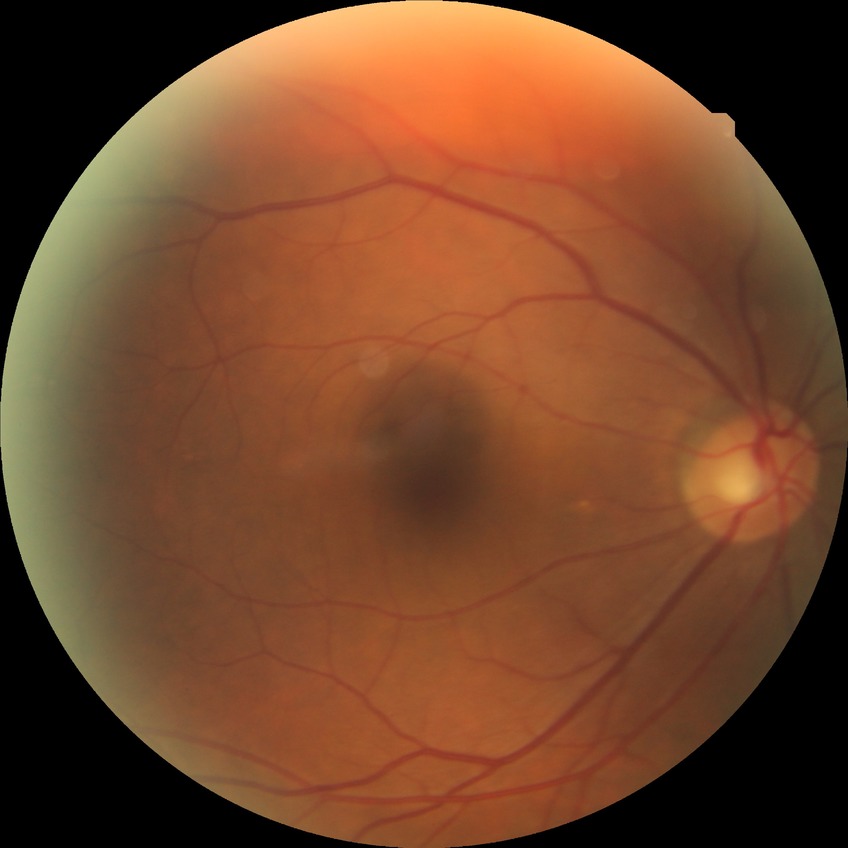

• diabetic retinopathy (DR): NDR (no diabetic retinopathy)